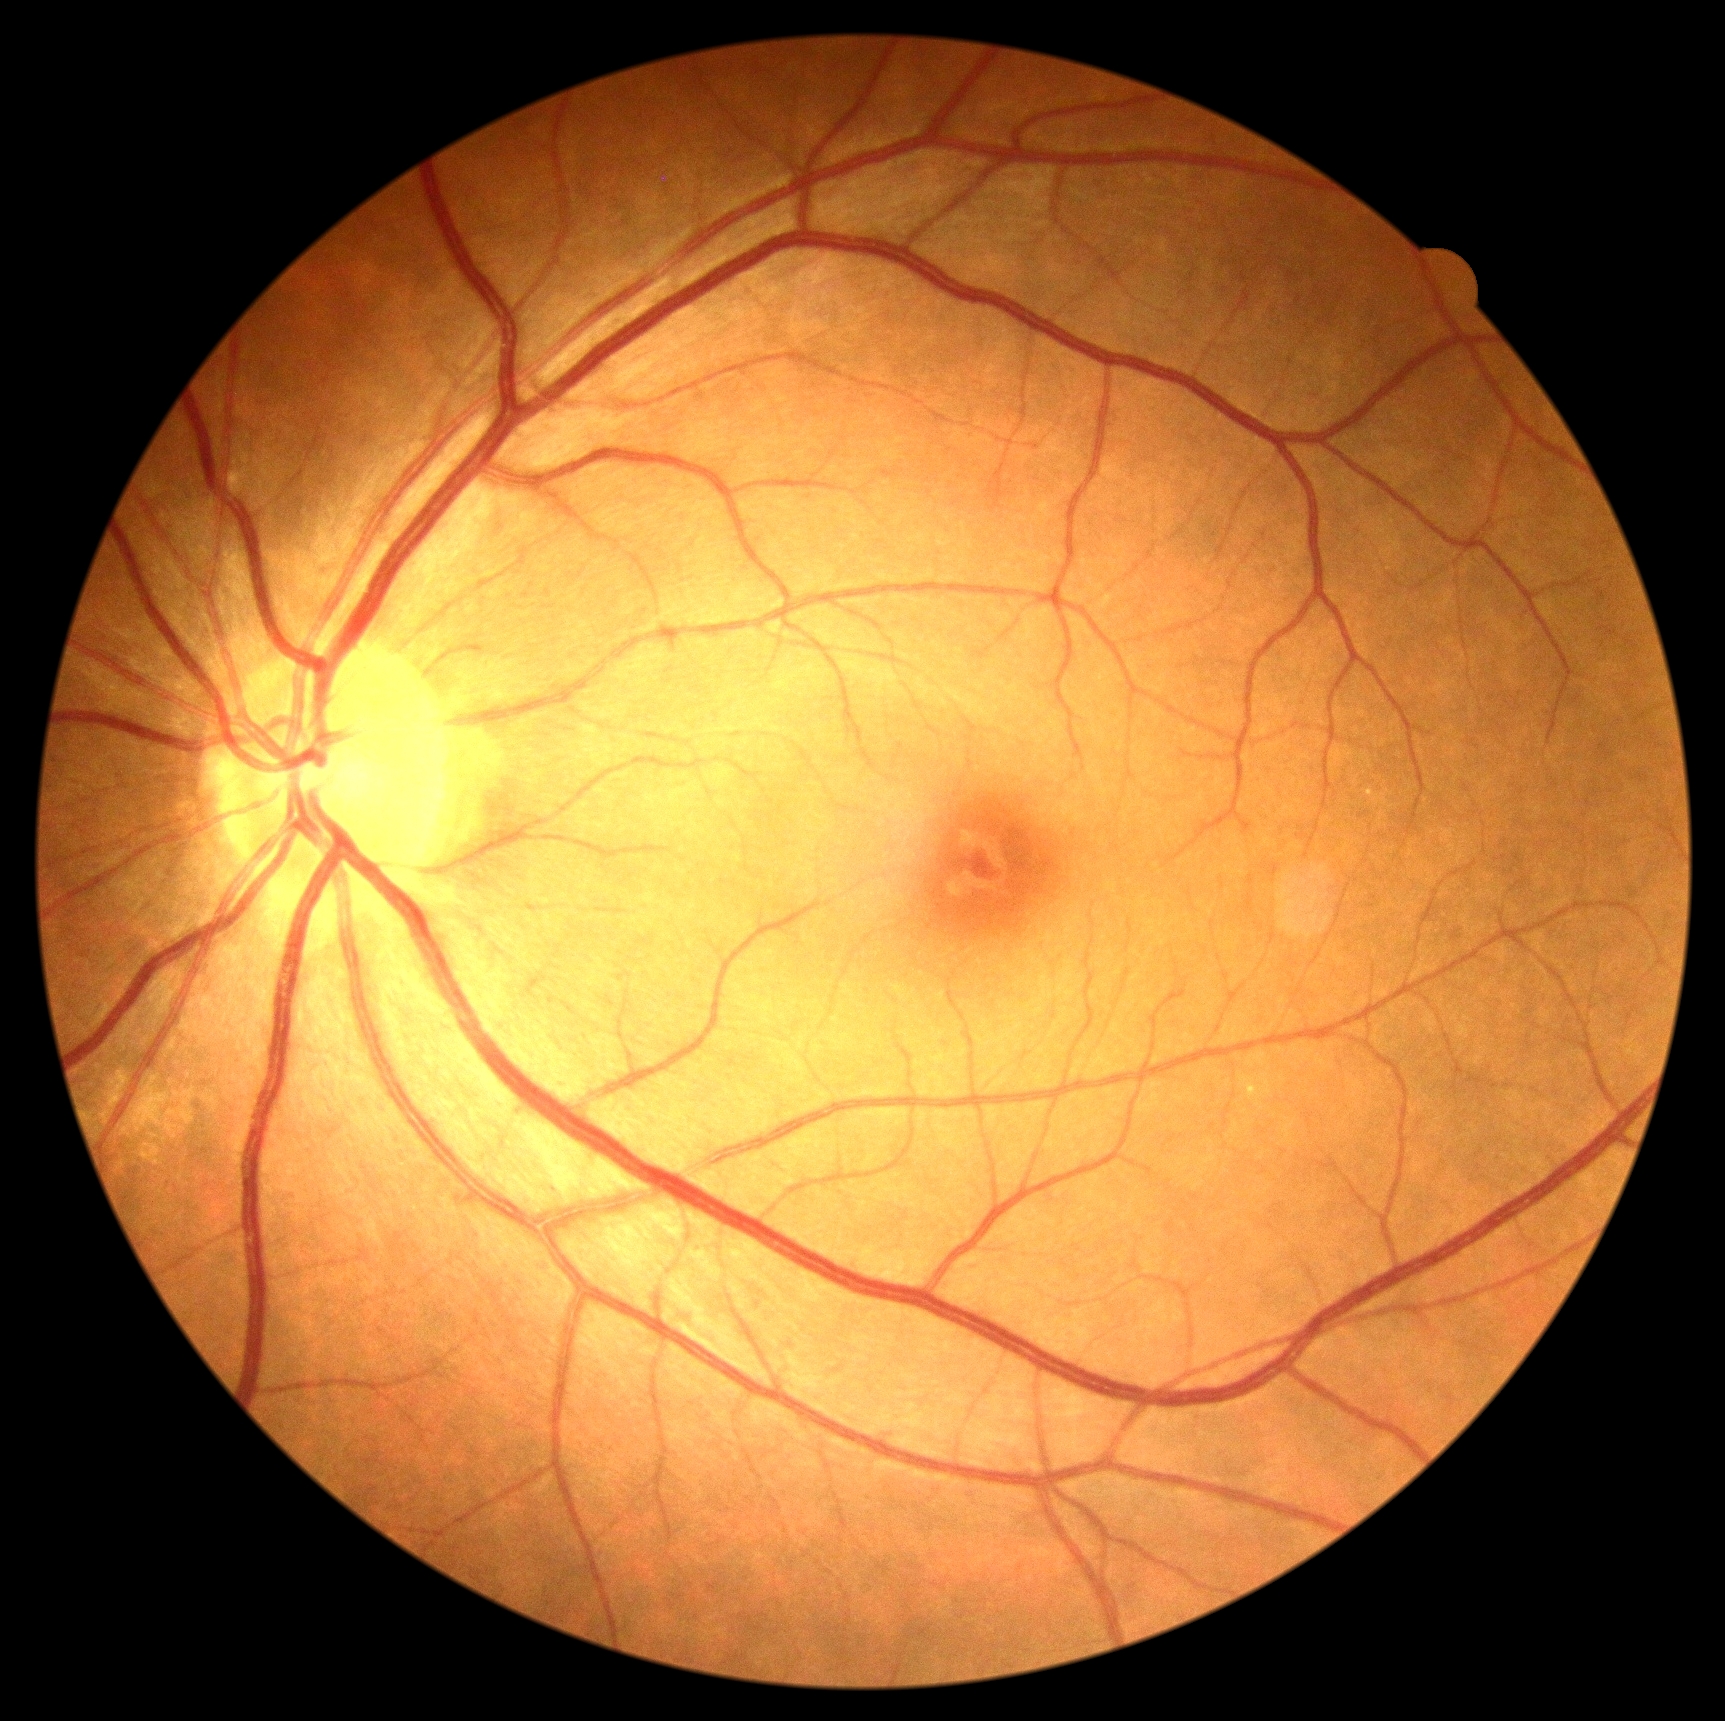

DR impression: negative for DR; diabetic retinopathy severity: grade 0 (no apparent retinopathy).